Fundus photo — 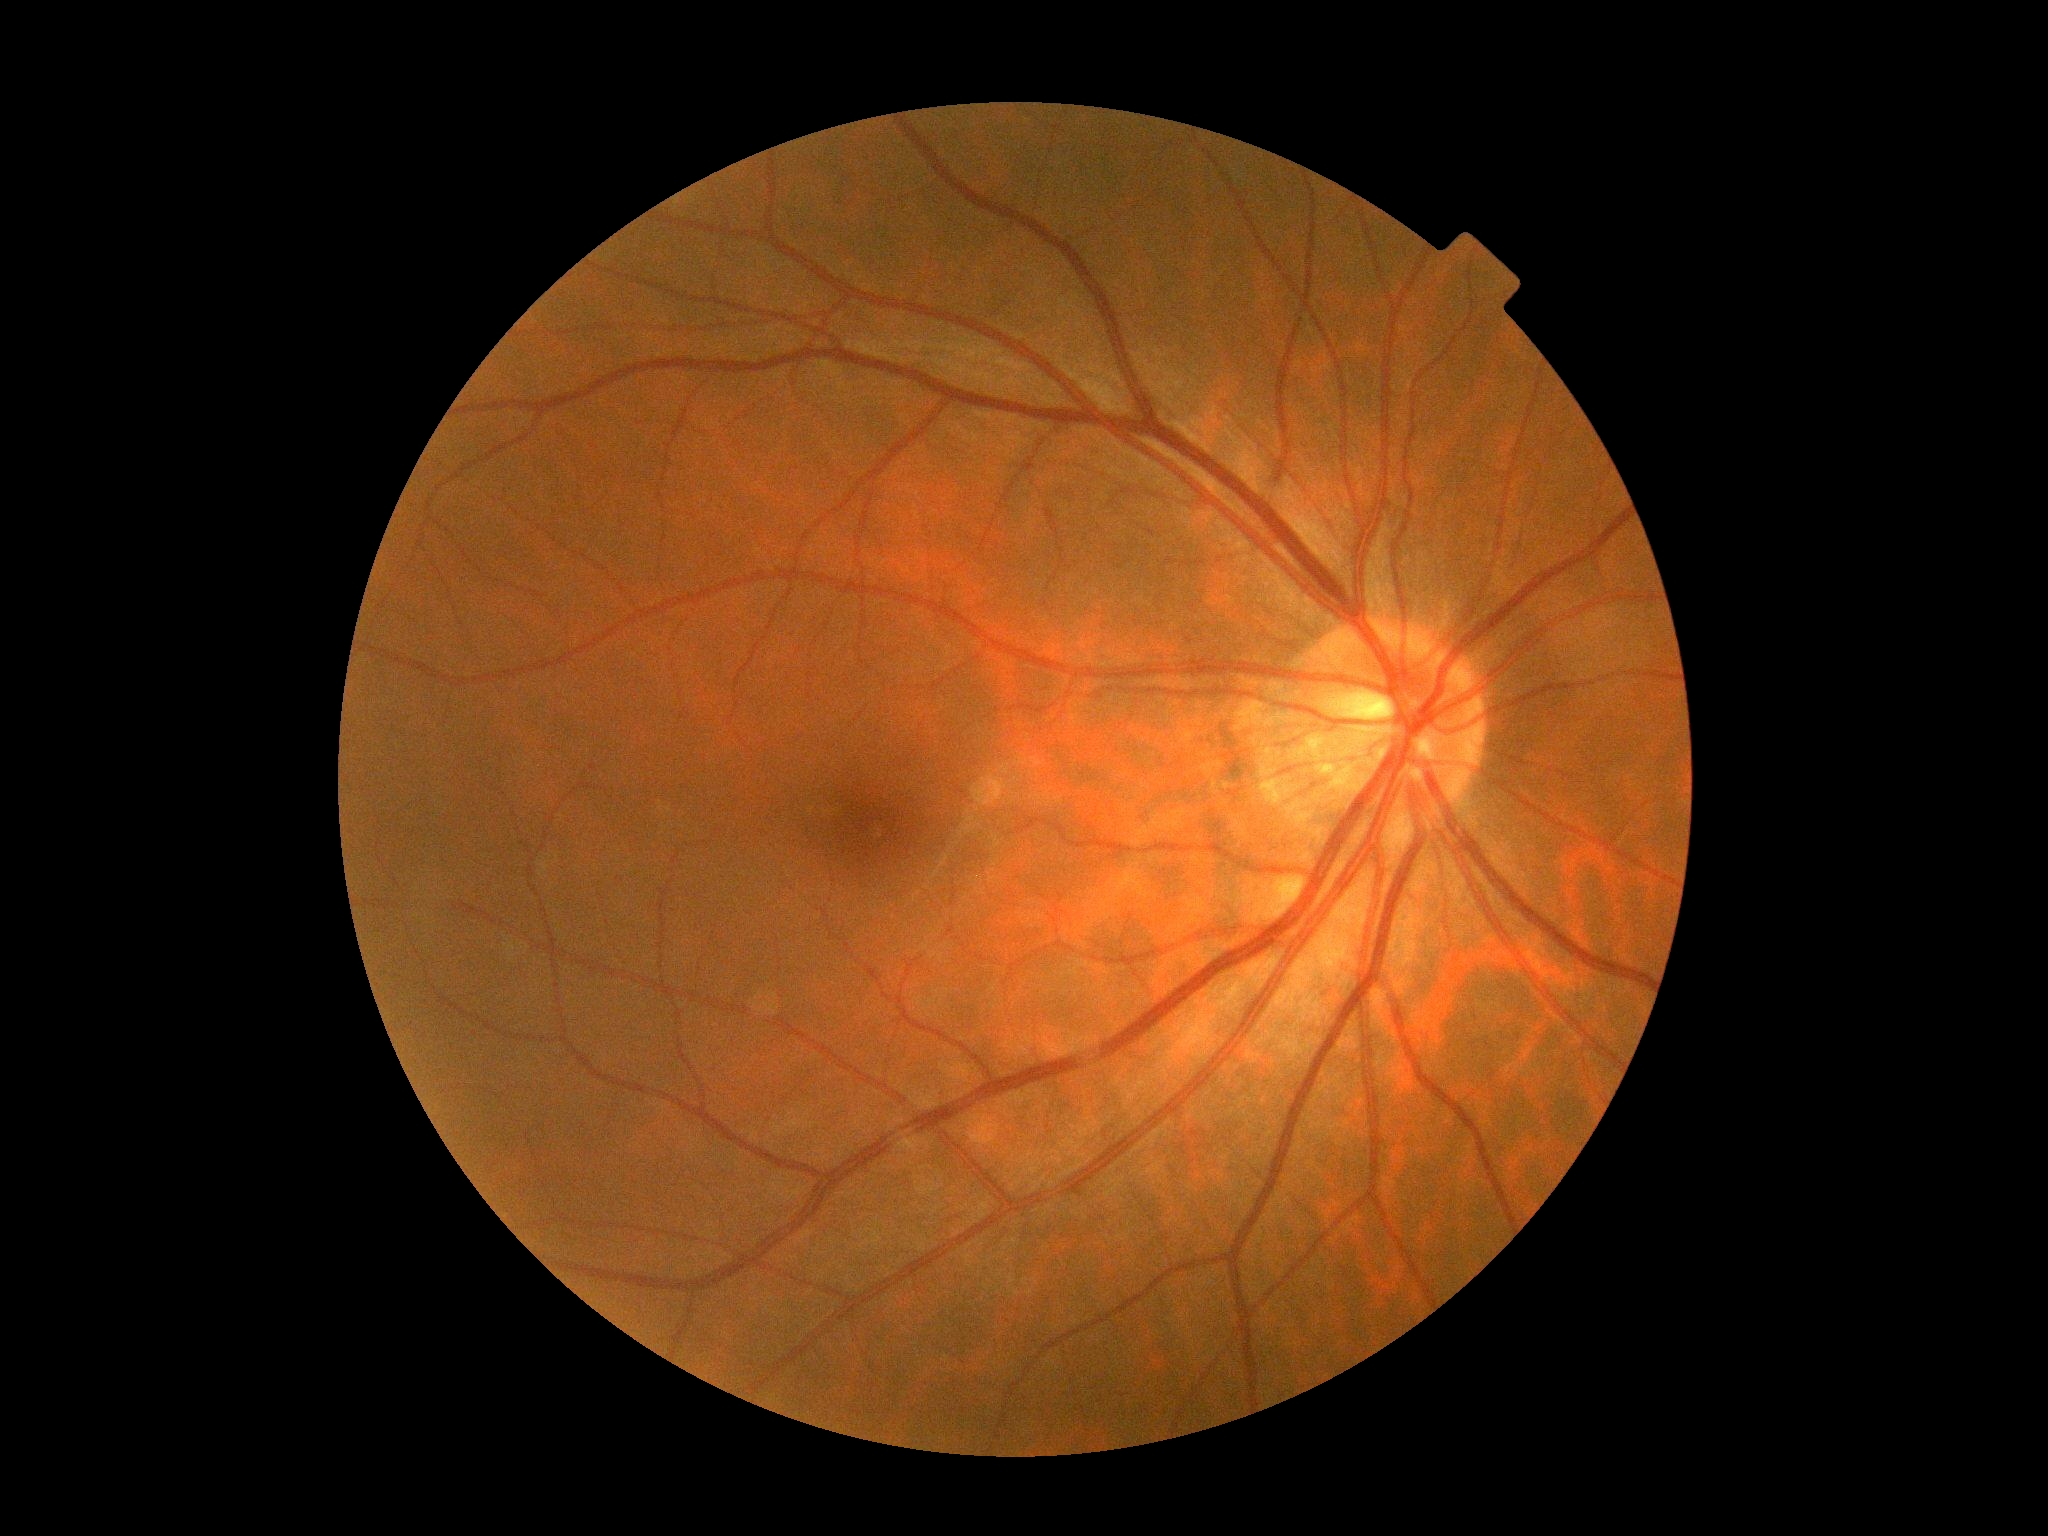
{
  "dr_grade": "grade 0 (no apparent retinopathy)",
  "dr_impression": "negative for DR"
}